1240 by 1240 pixels; pediatric wide-field fundus photograph; captured with the Phoenix ICON (100° field of view) — 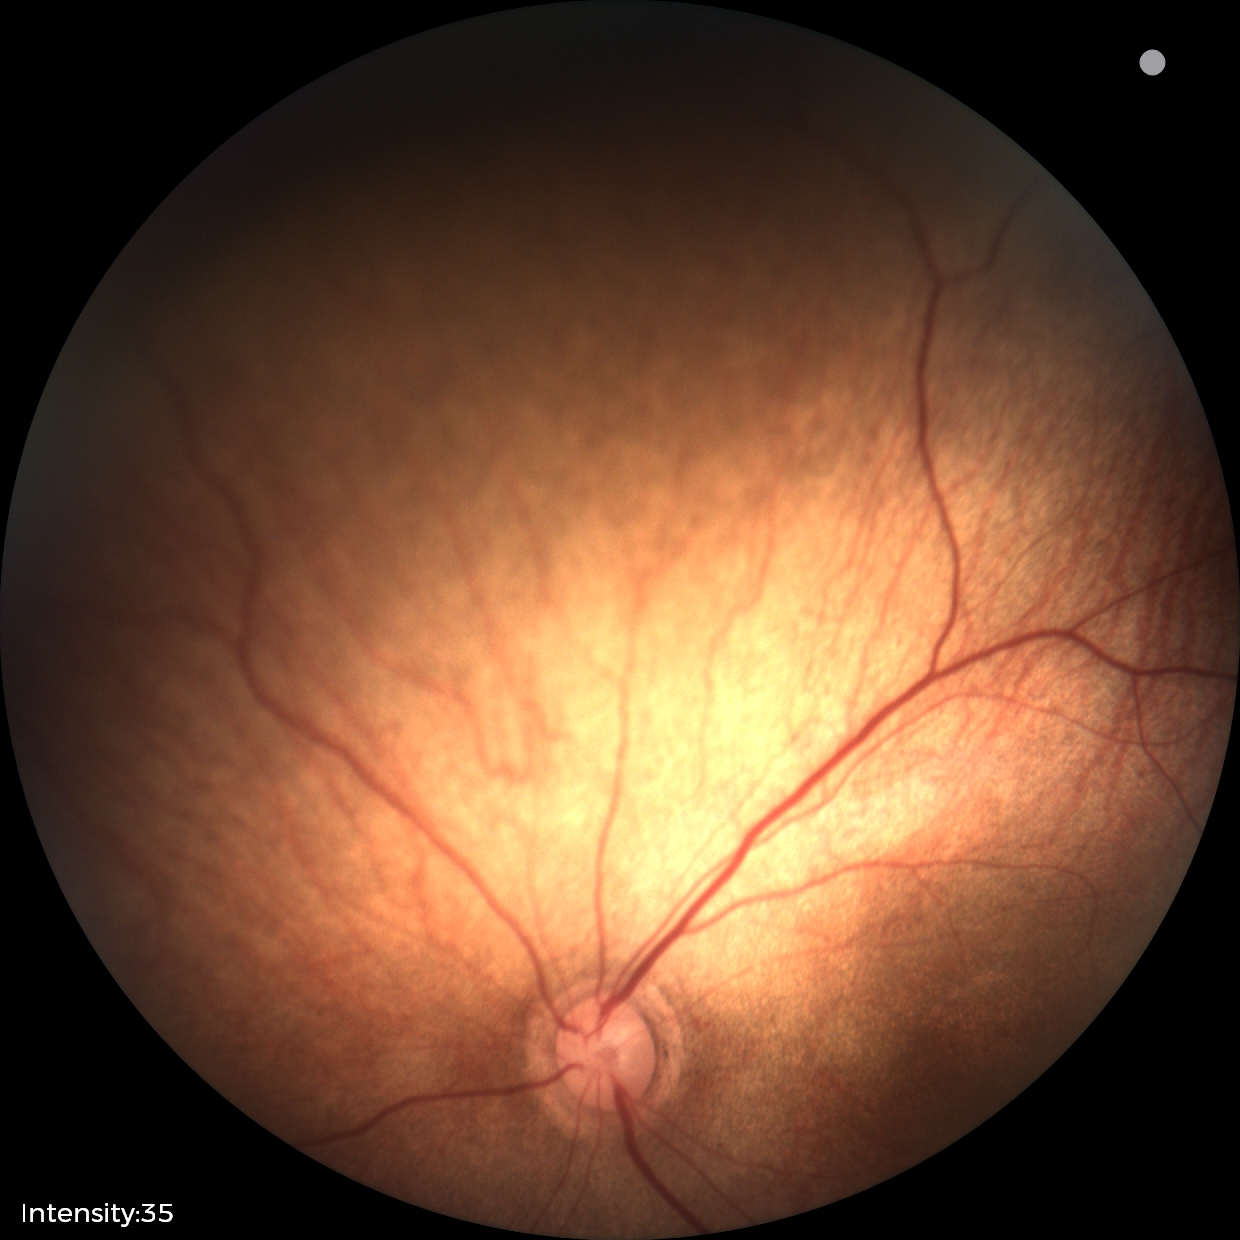
Screening examination diagnosed as physiological.